Modified Davis classification: 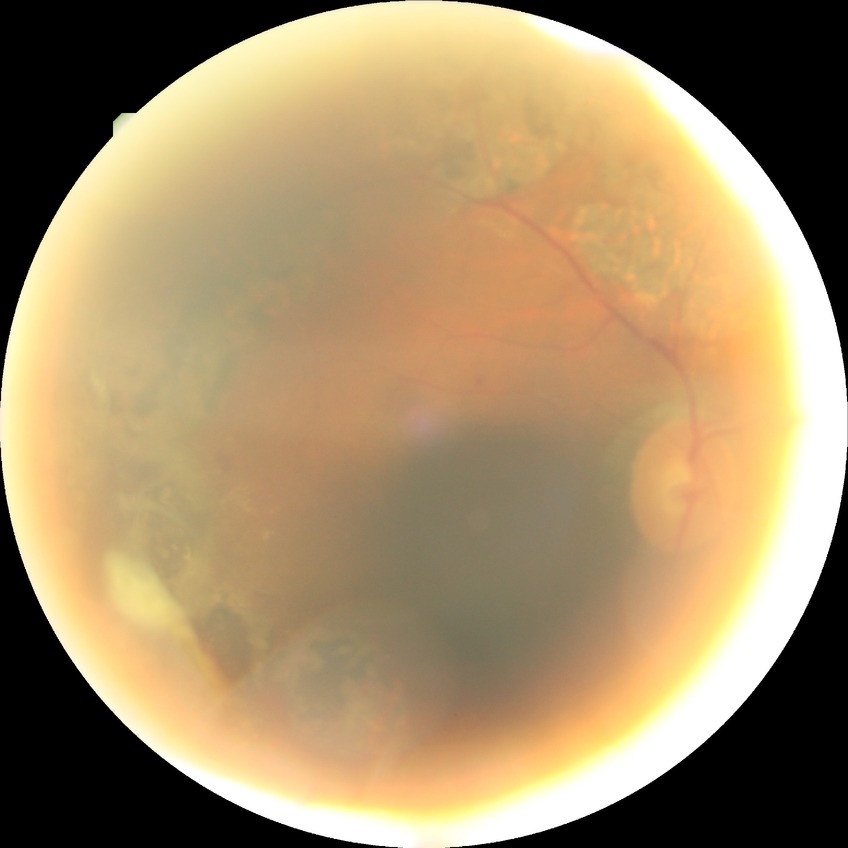

retinopathy stage=proliferative diabetic retinopathy.